2048x1536px: 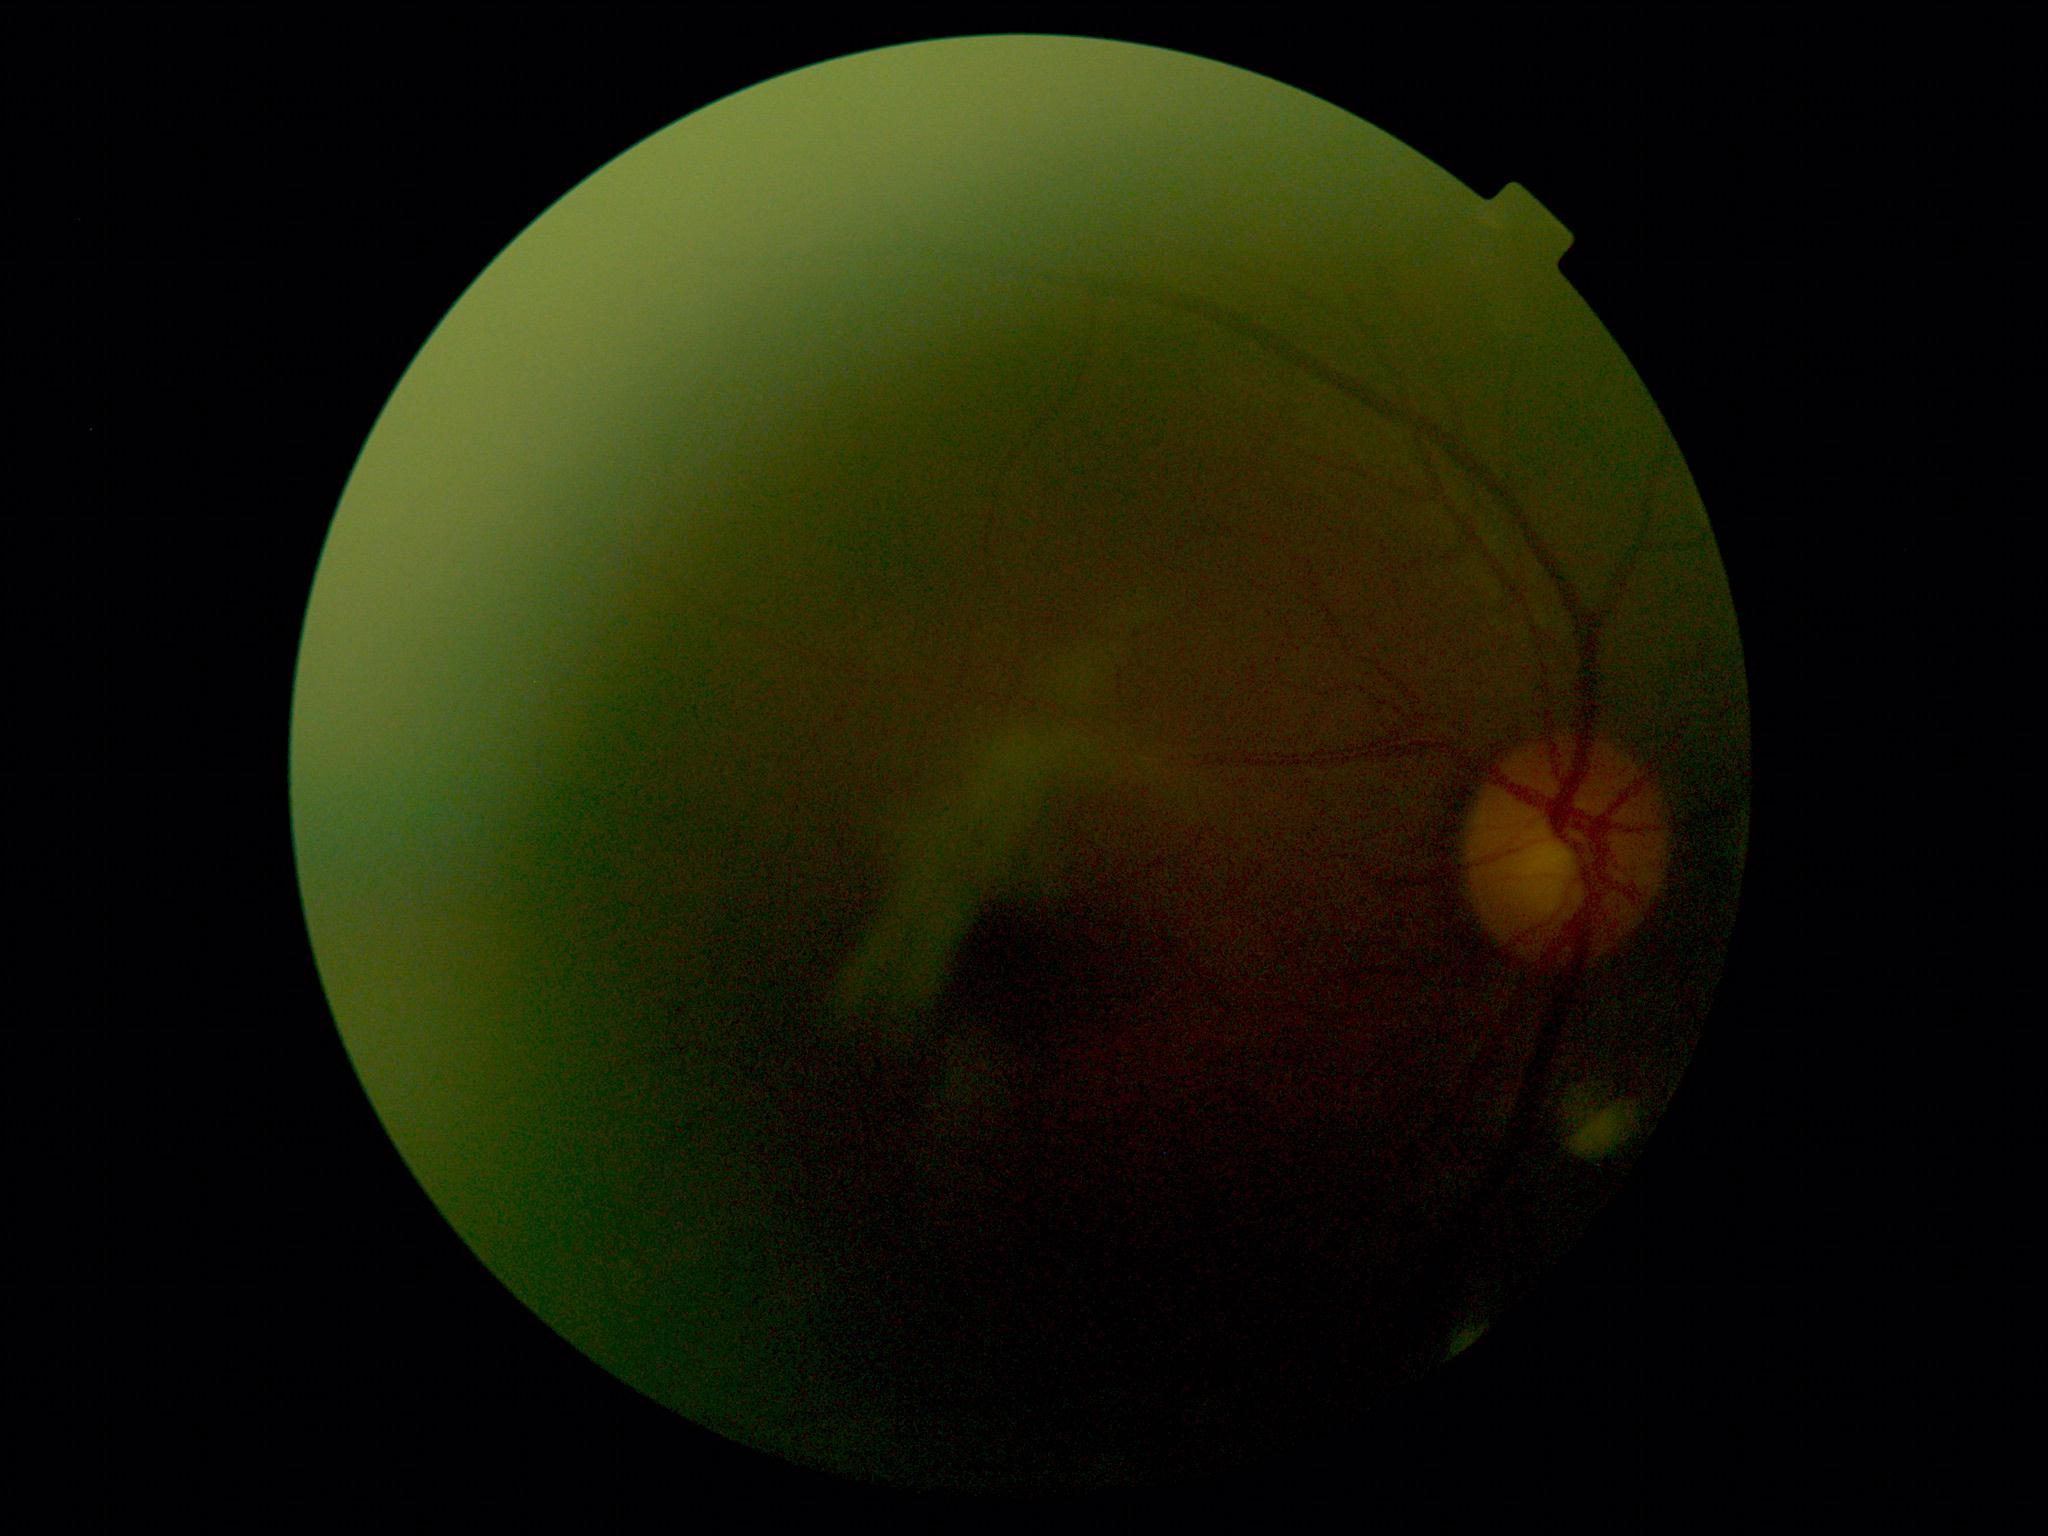
DR is ungradable. Image quality is insufficient for diabetic retinopathy assessment.